Modified Davis grading.
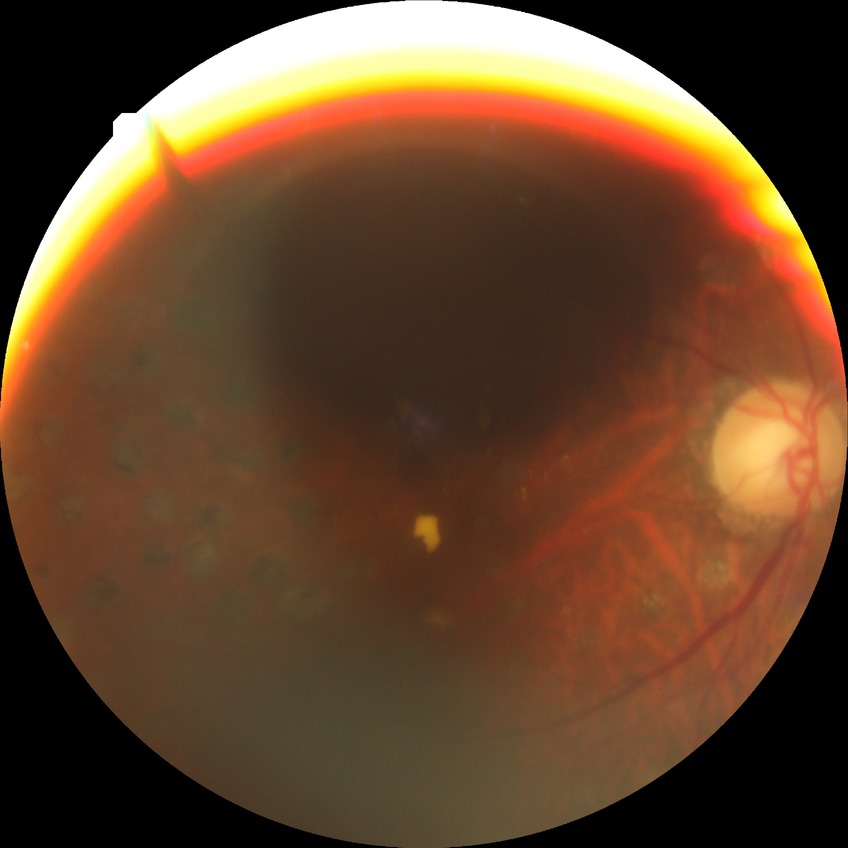

Diabetic retinopathy stage is proliferative diabetic retinopathy.